CFP; 2048x1536.
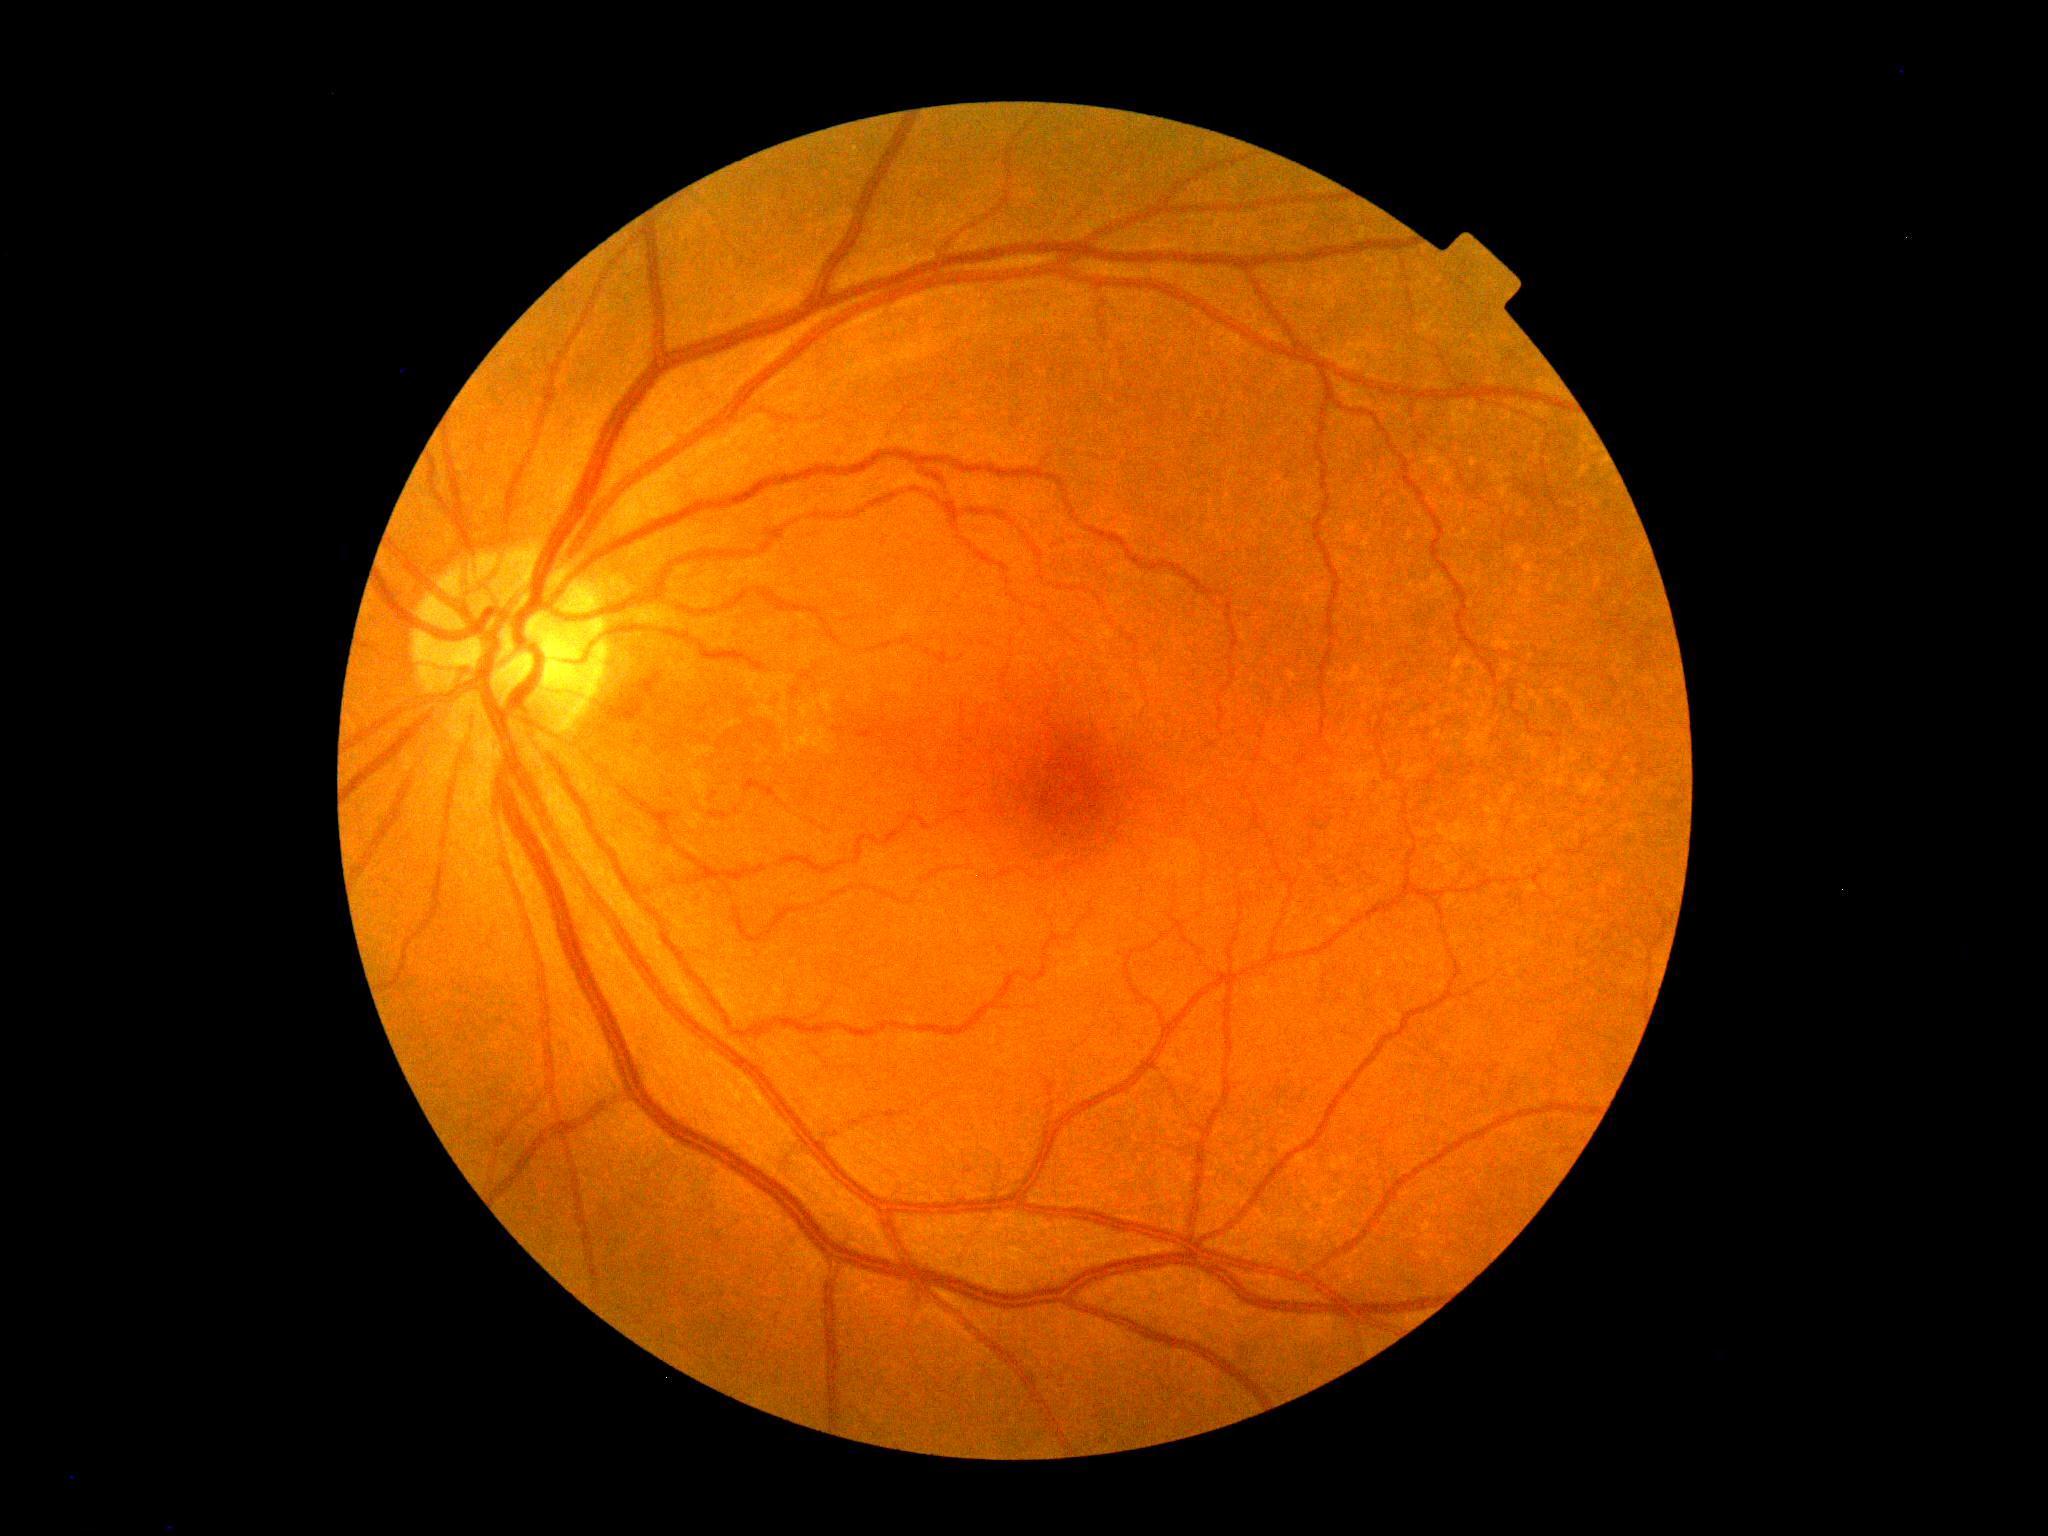

DR stage = grade 0.